Optic nerve head crop, captured on a Nidek AFC-330 fundus camera
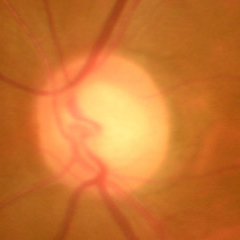

Q: Is glaucoma present?
A: Early glaucomatous changes.